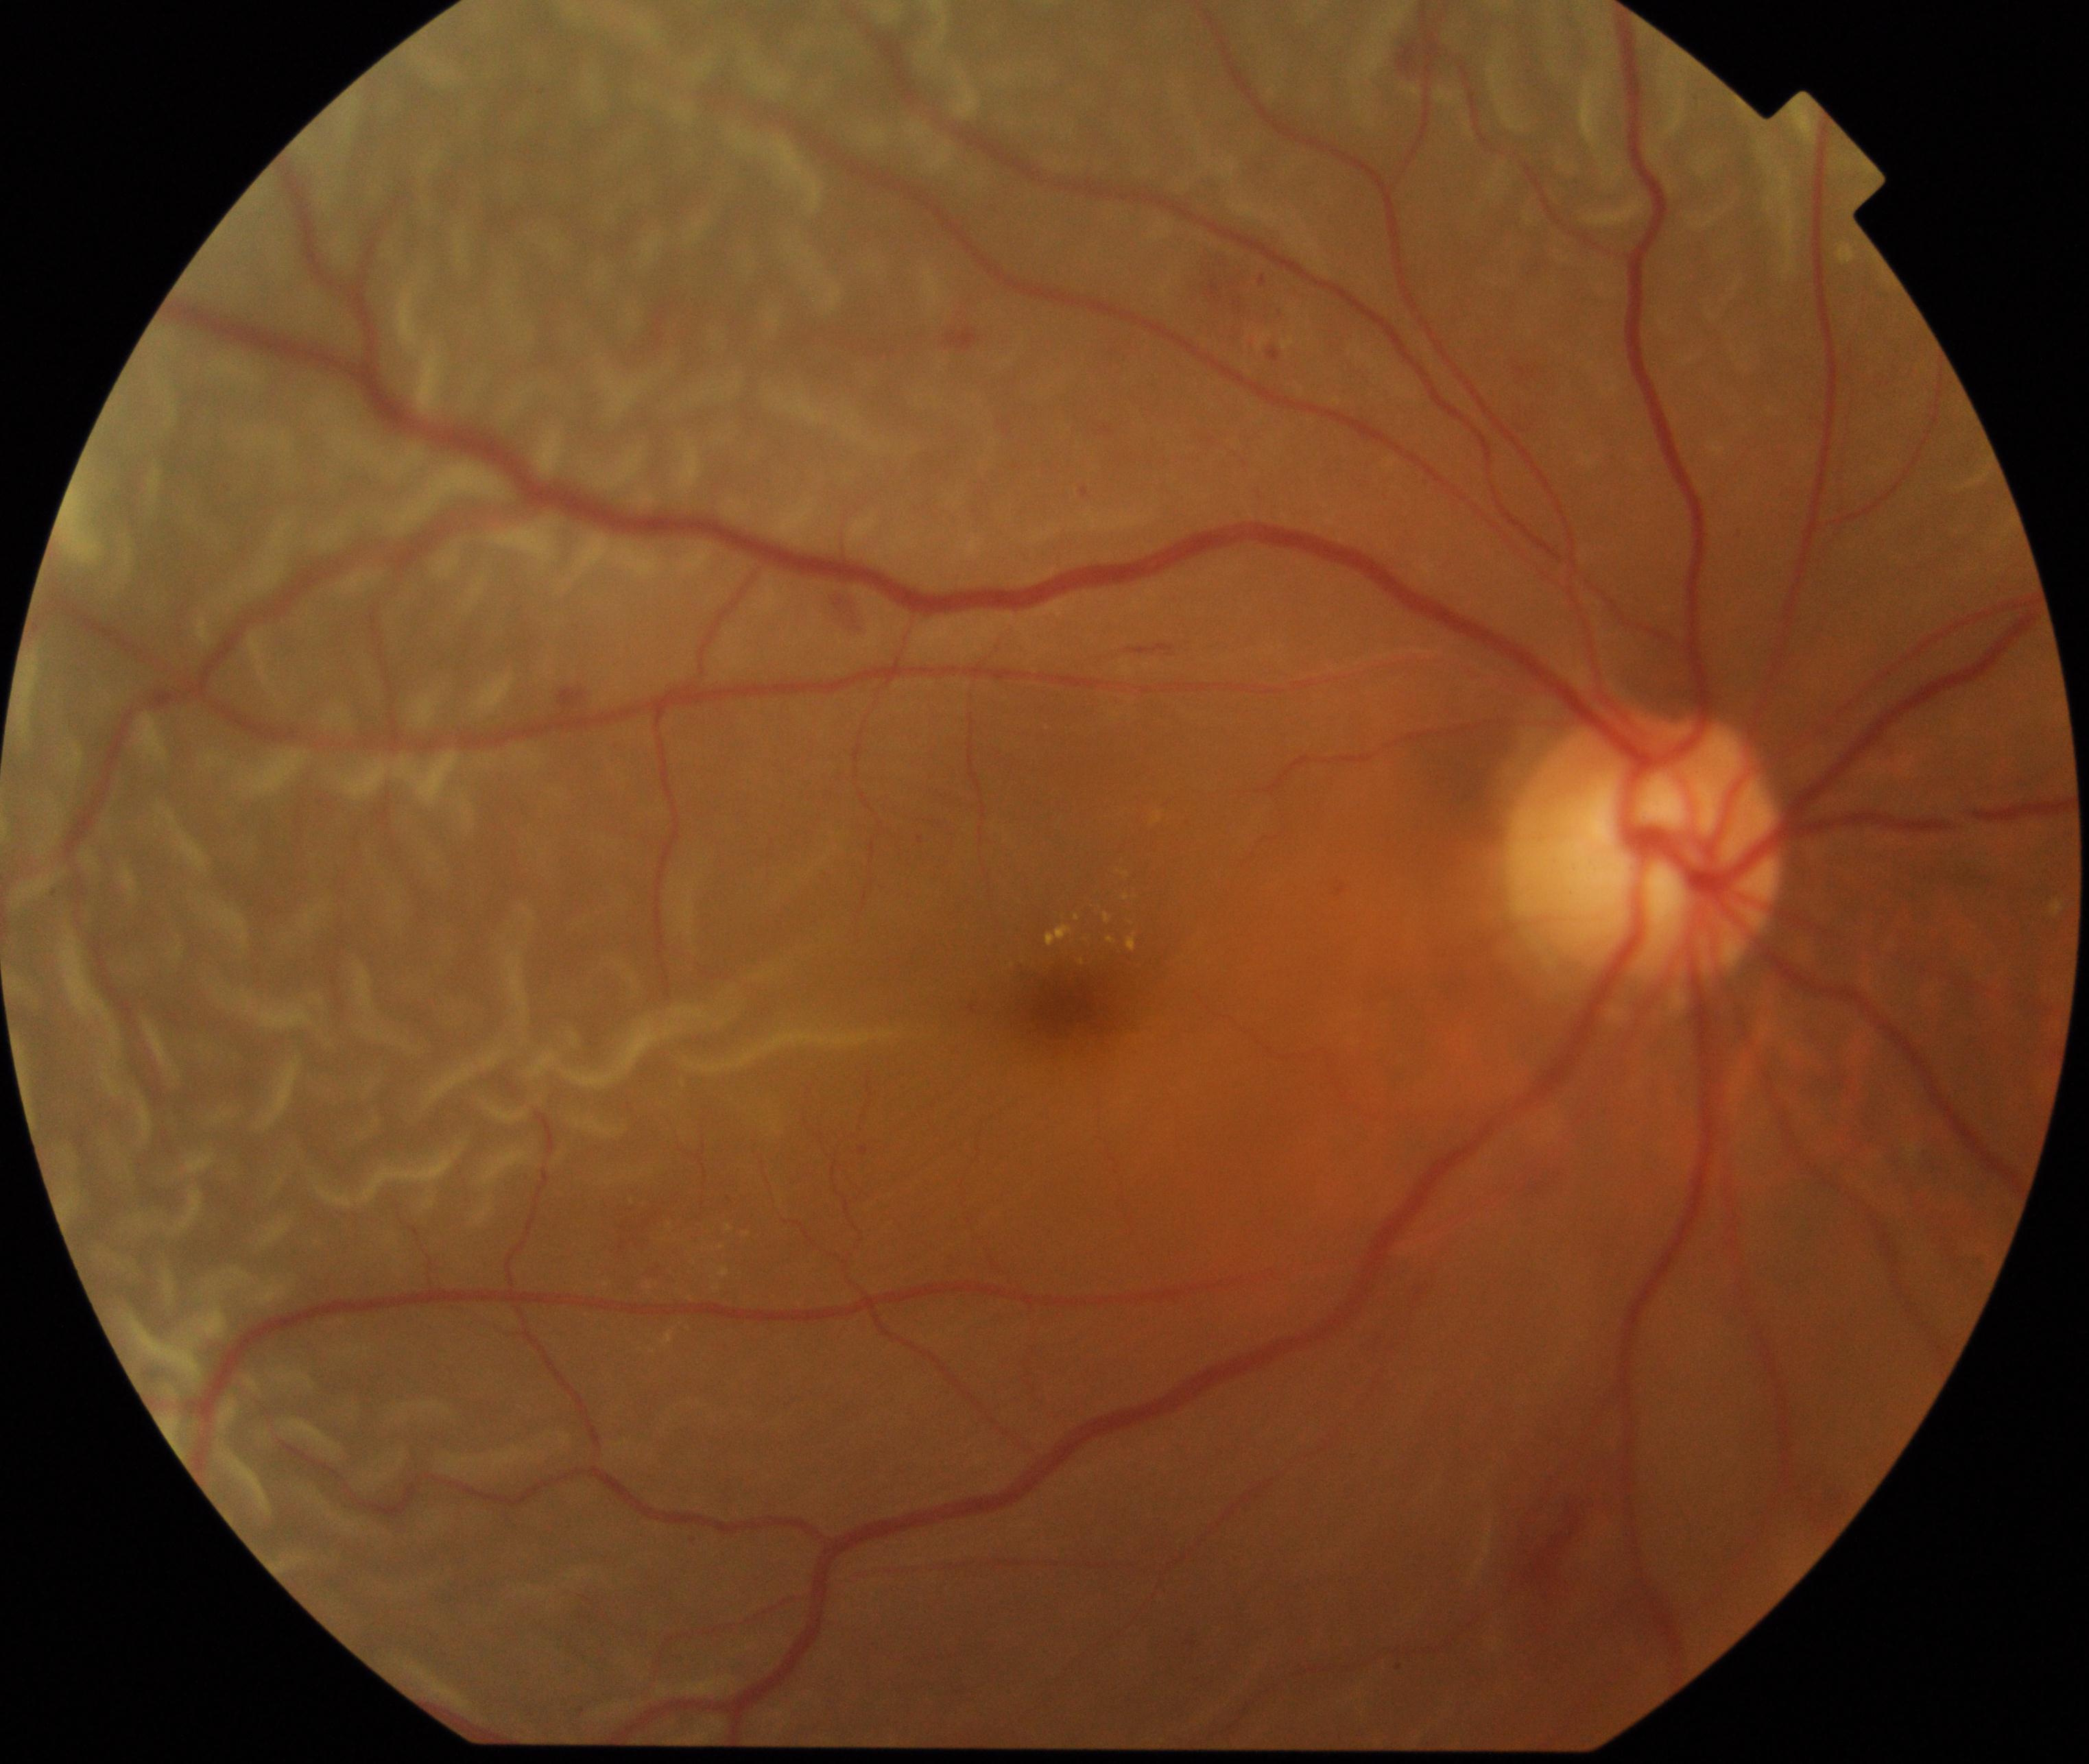

Classification: rhegmatogenous retinal detachment. Characterized by slightly opaque, convex or corrugated appearance of elevated retina, sometimes with retinal breaks in view.